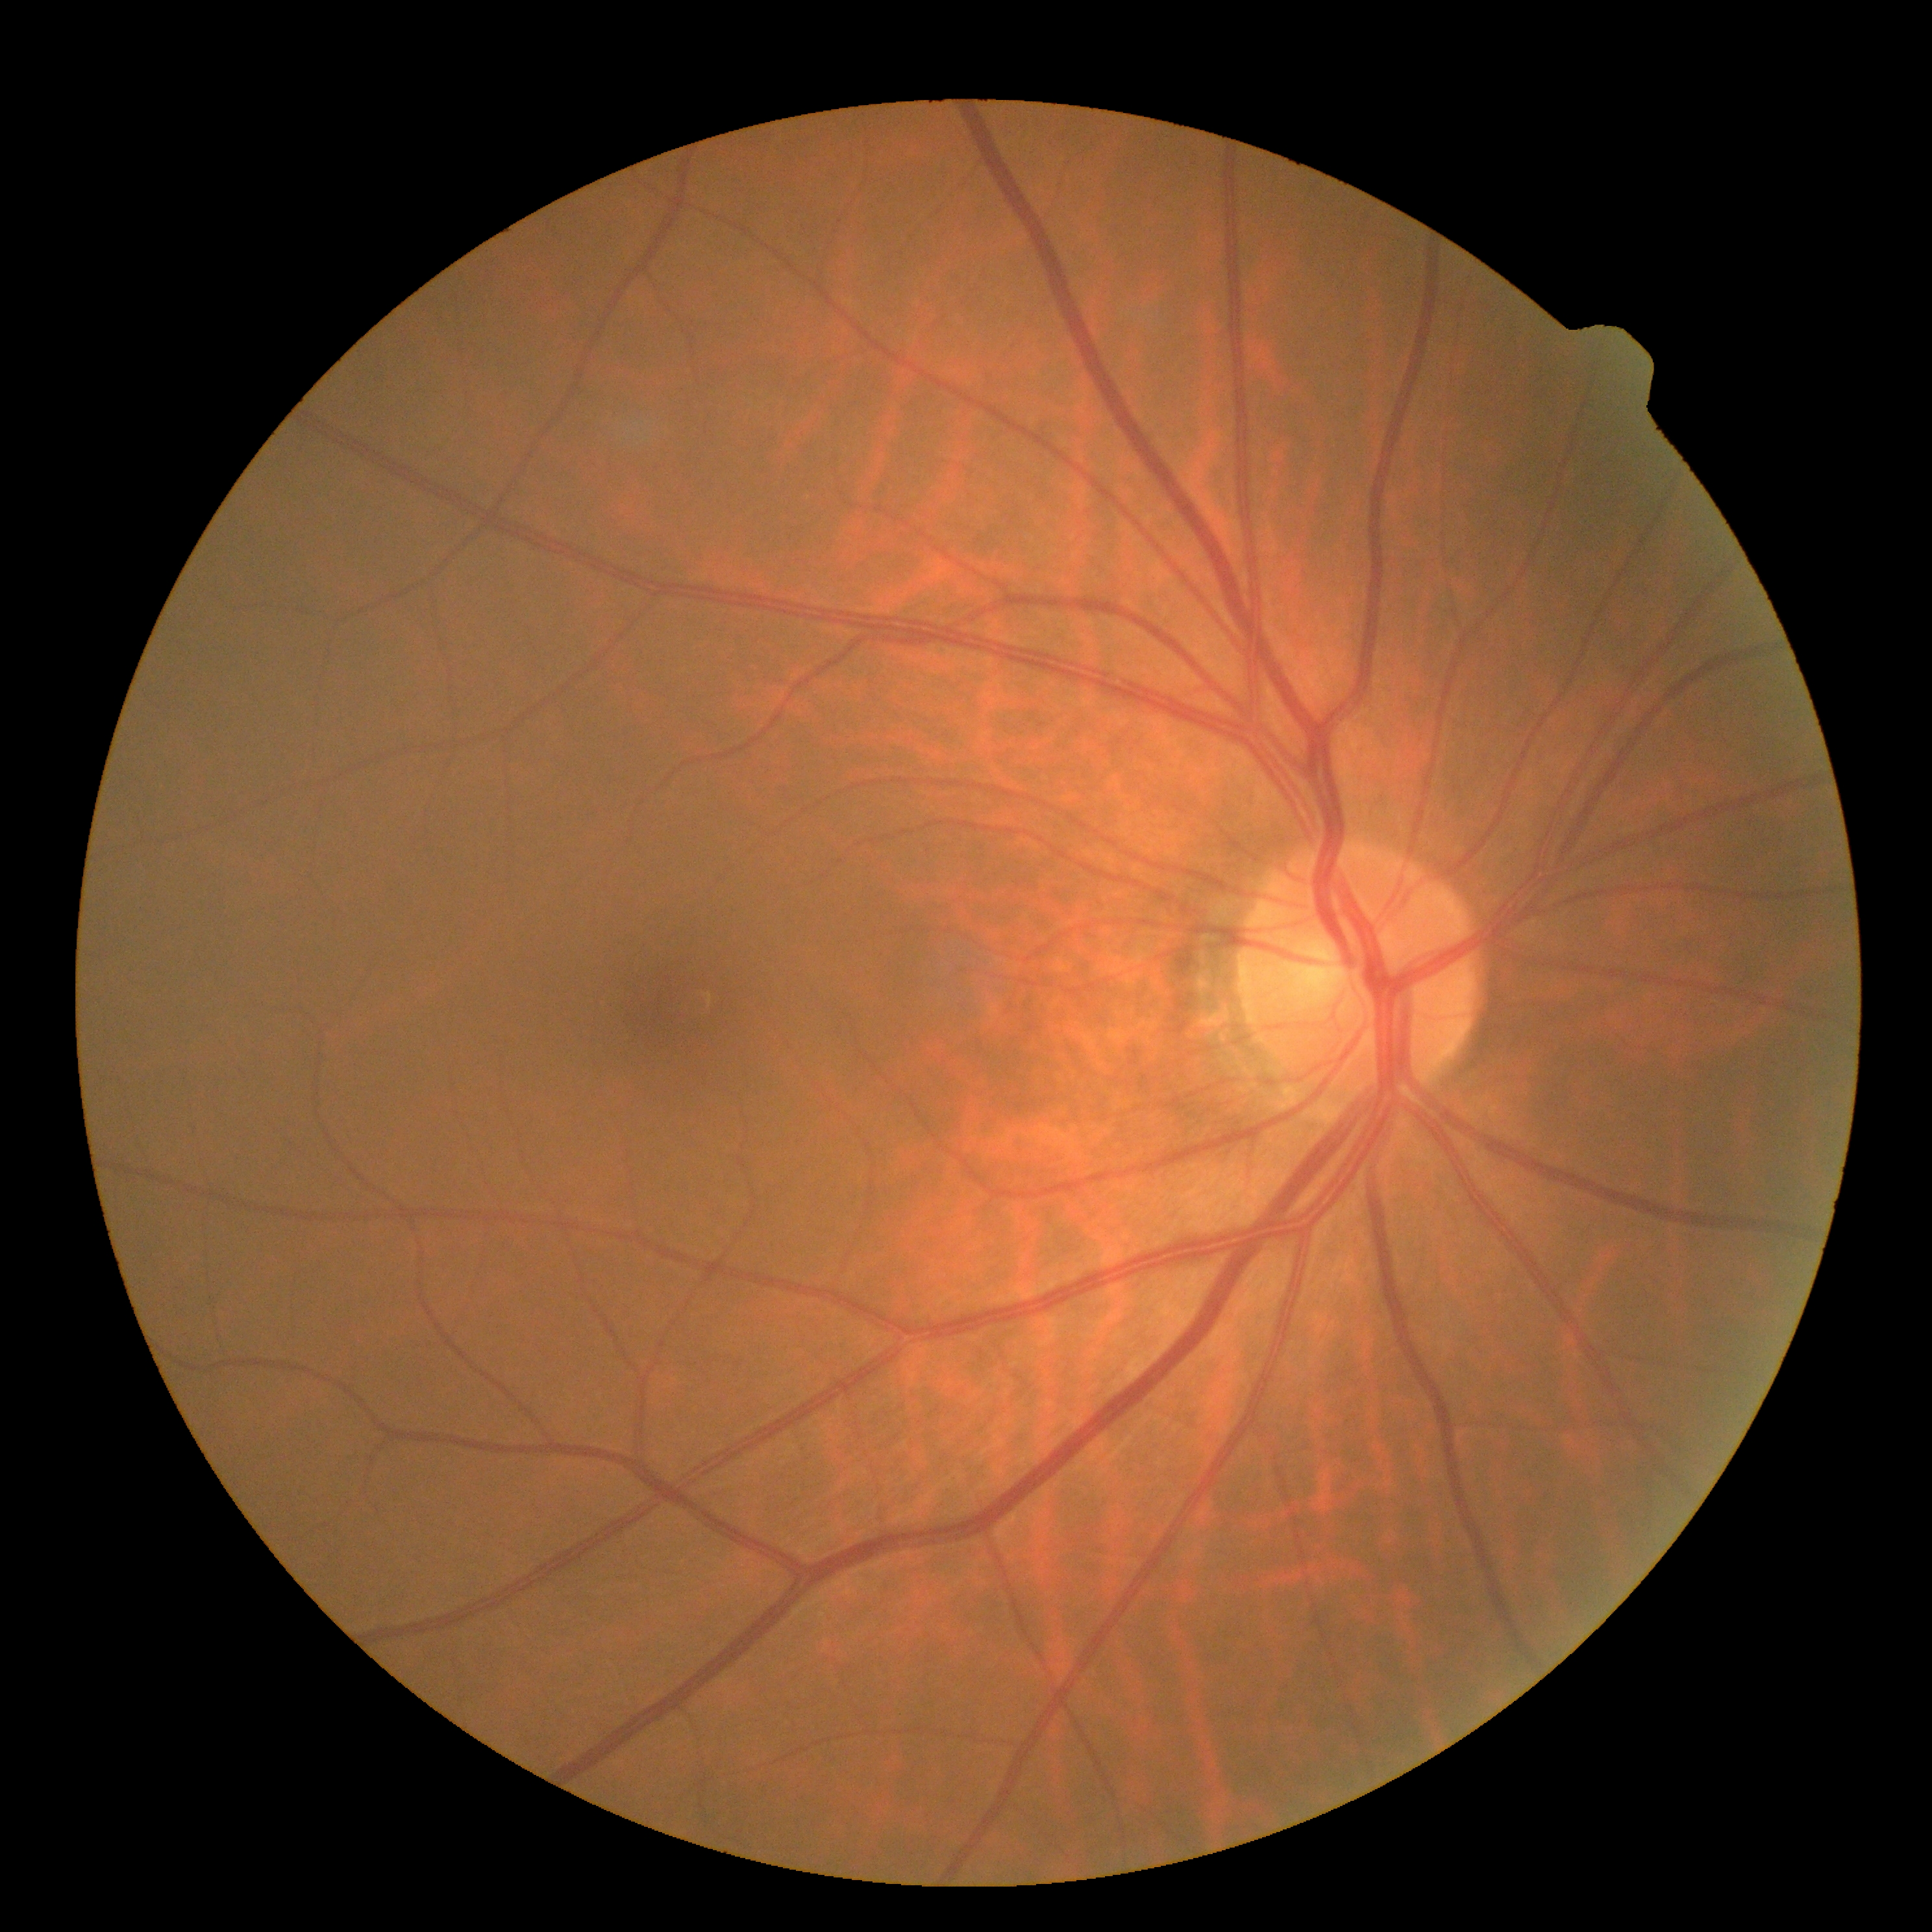

– diabetic retinopathy severity: no apparent diabetic retinopathy (grade 0)